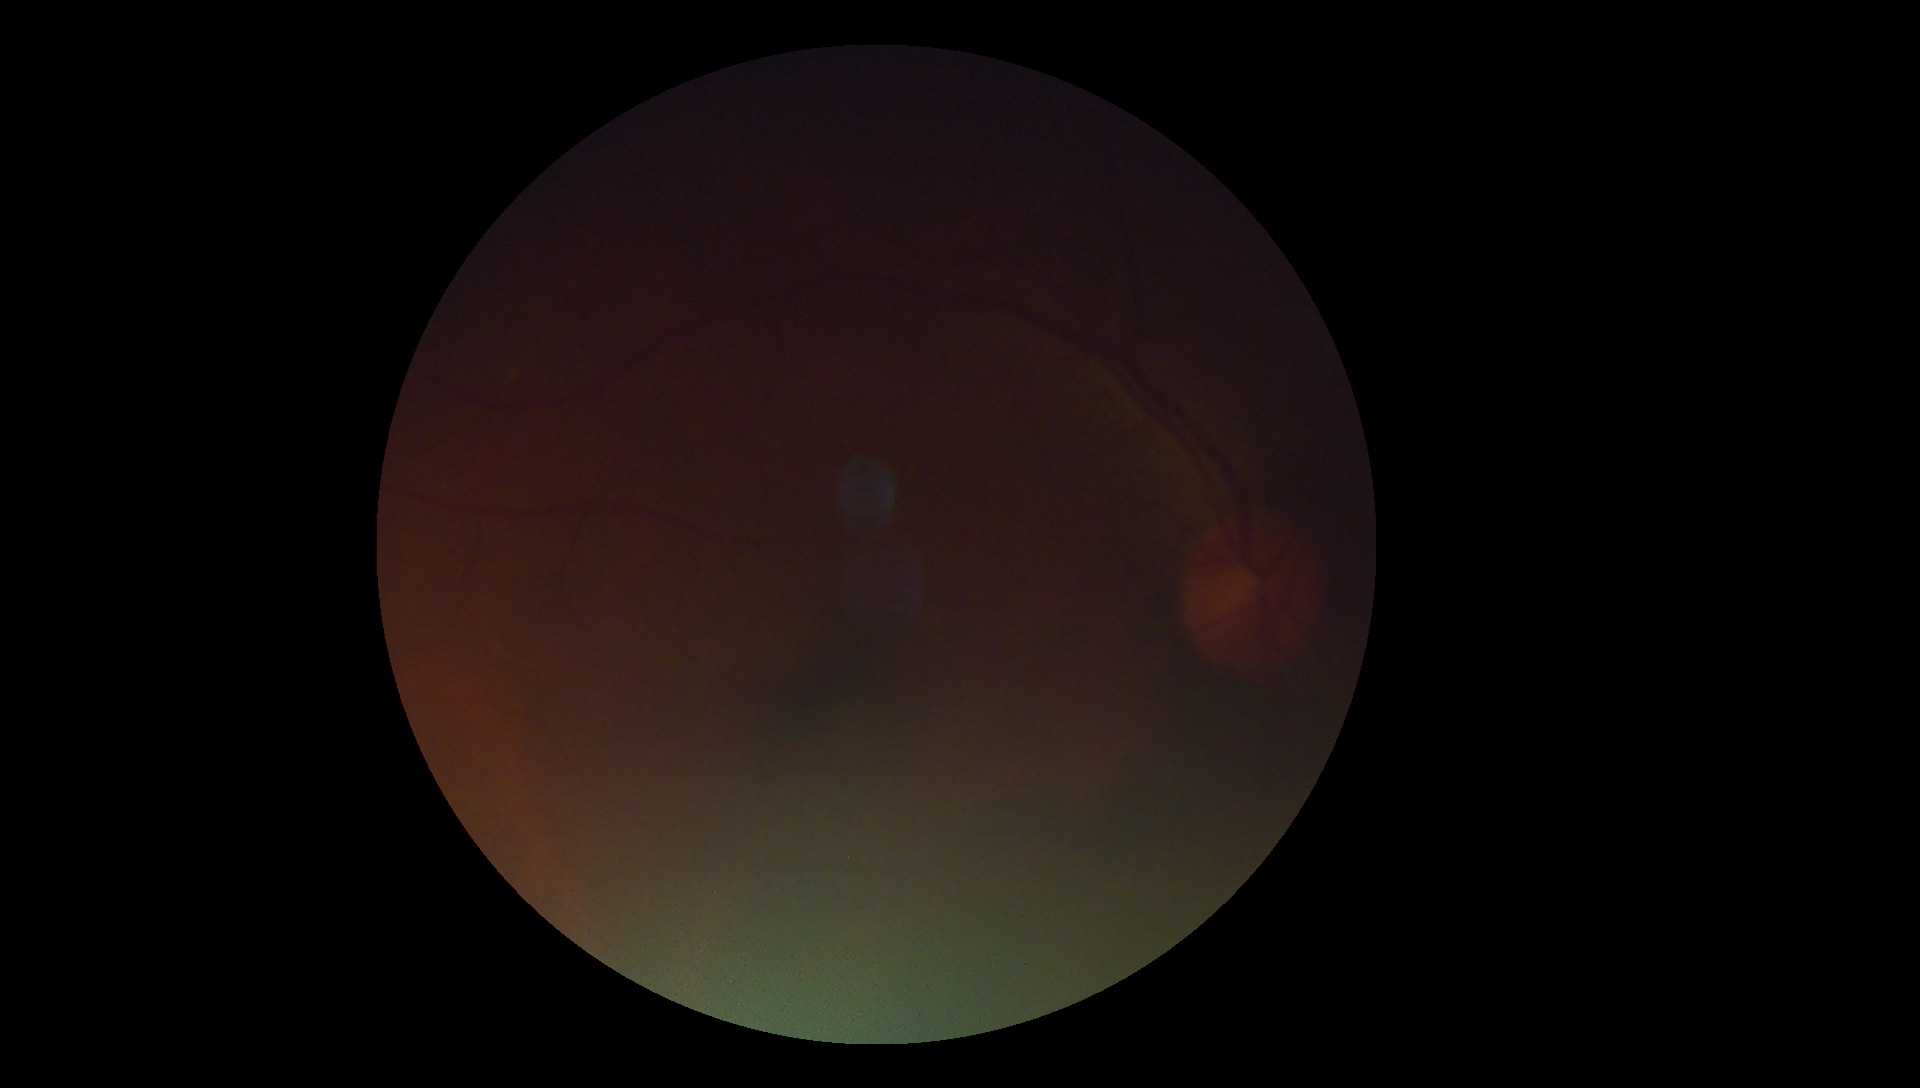 Ungradable image — DR severity cannot be determined. Retinopathy: ungradable due to poor image quality.